RetCam wide-field infant fundus image · 1440 x 1080 pixels · 130° field of view (Natus RetCam Envision) — 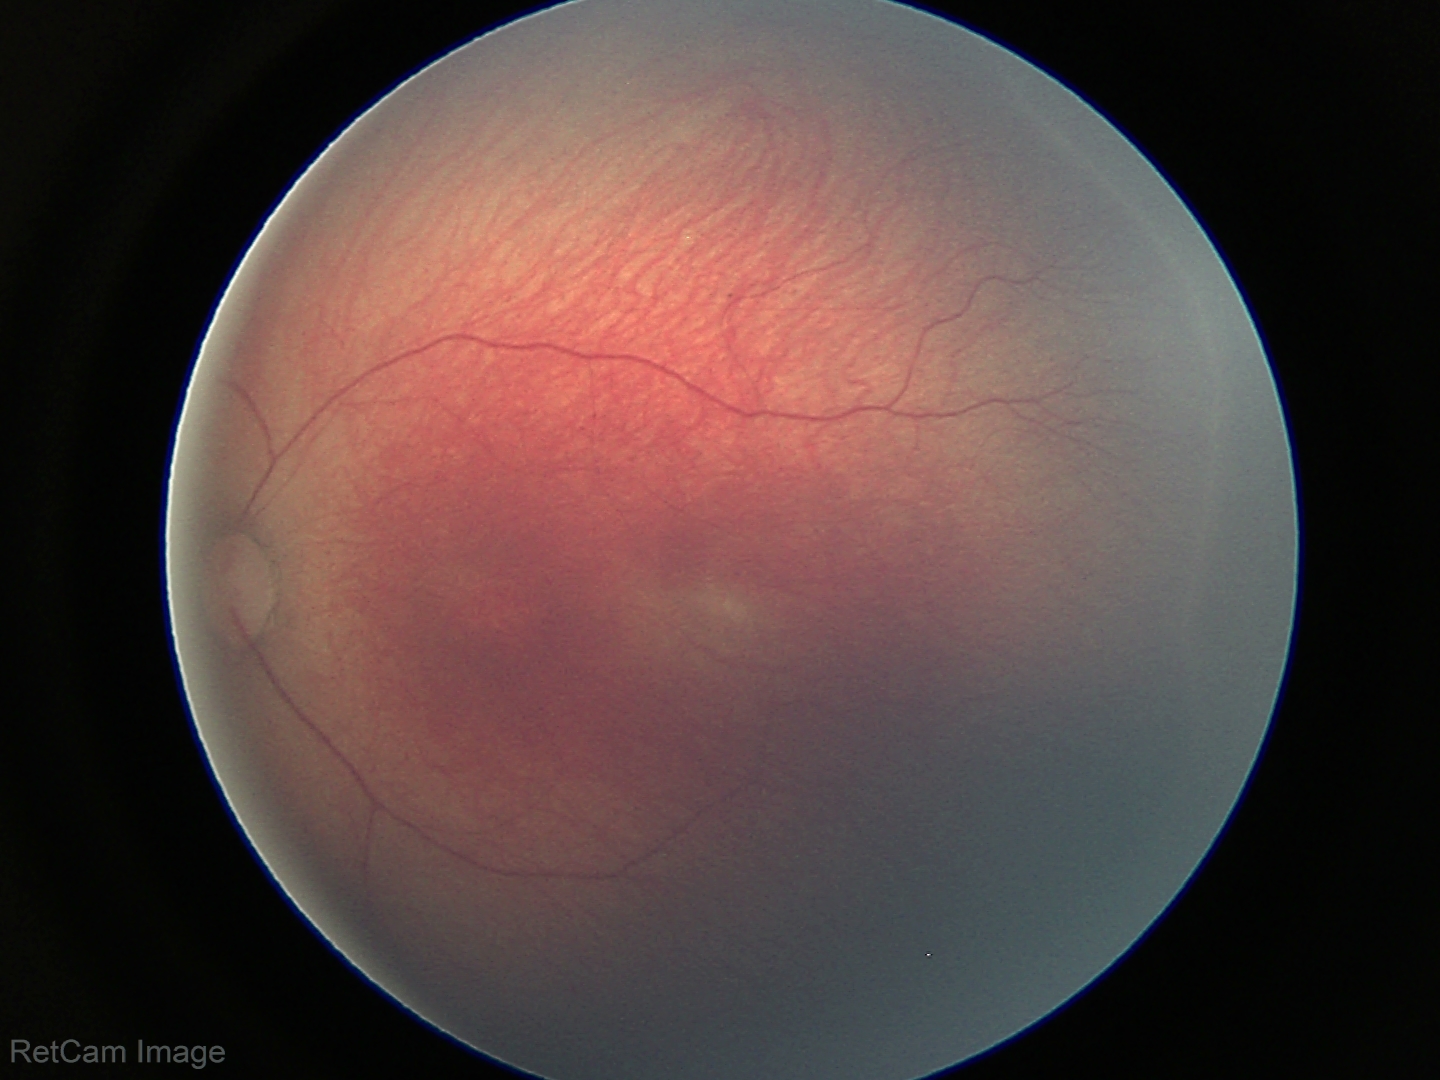 Diagnosis from this screening exam: retinopathy of prematurity (ROP) stage 2 — ridge with height and width at the demarcation line.
Plus disease absent.